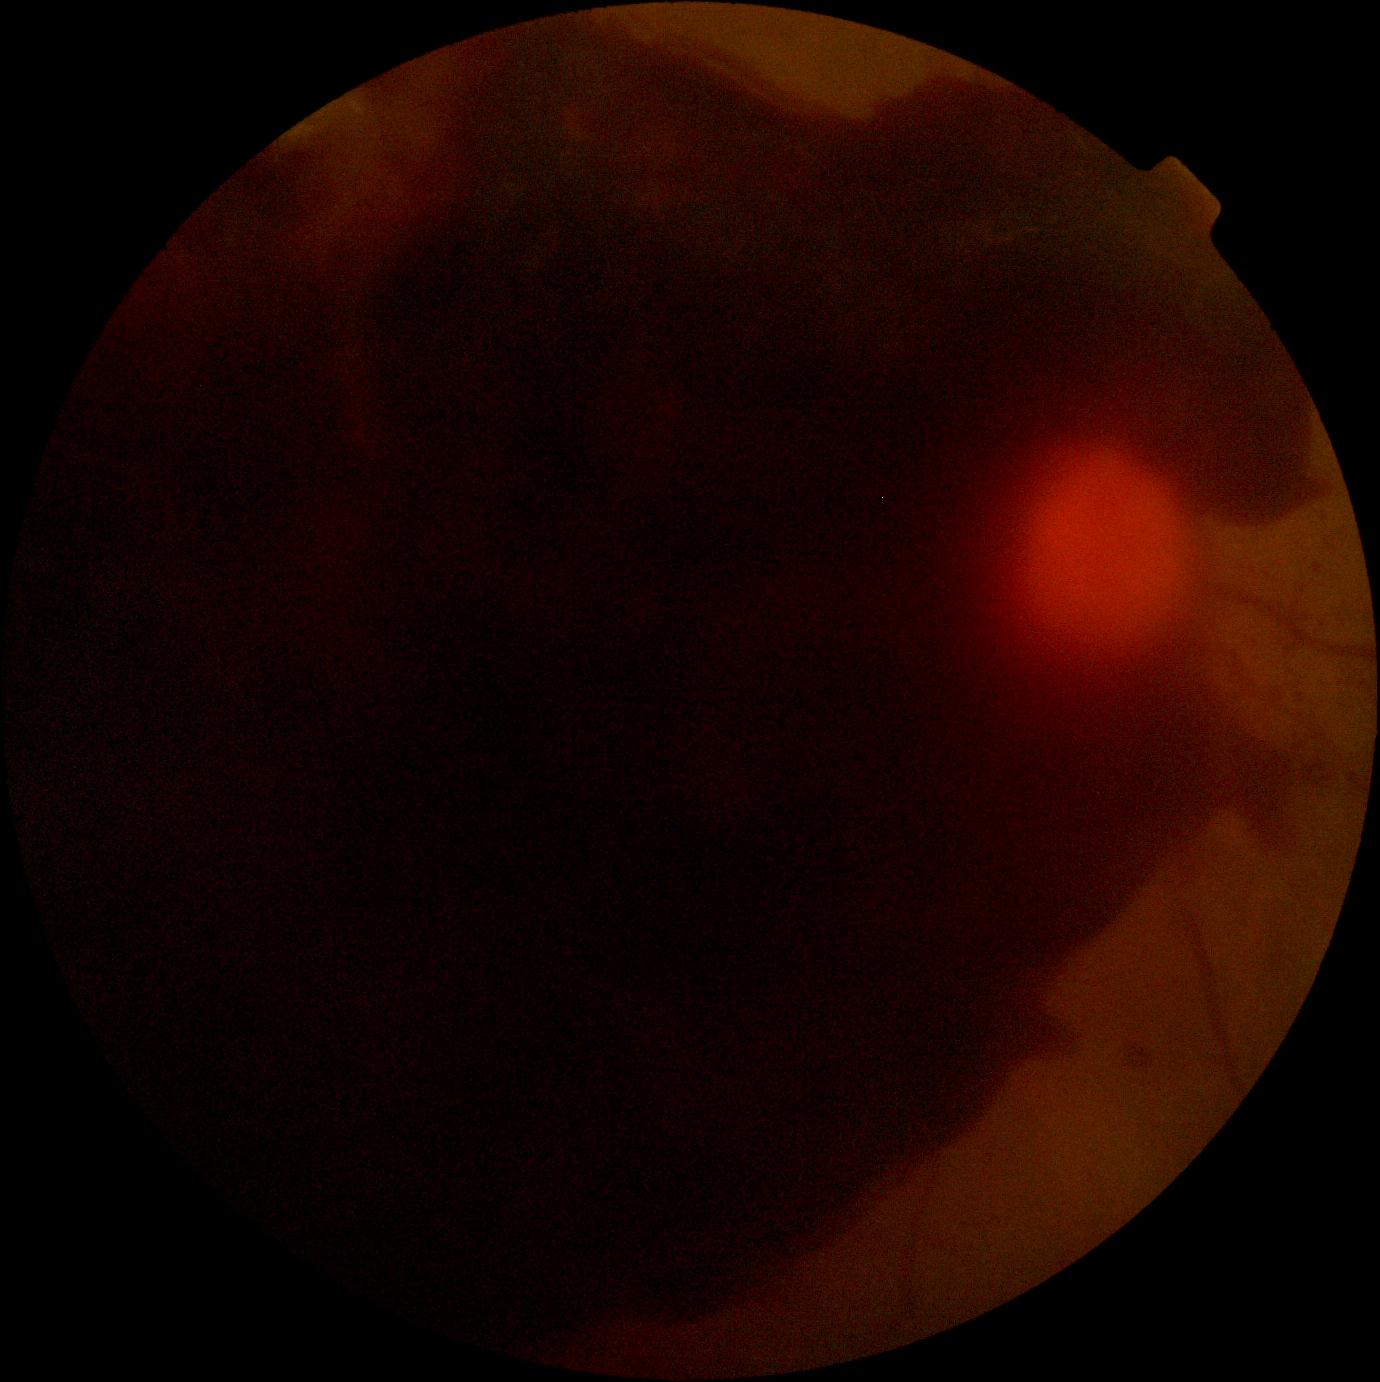

The retinopathy is classified as proliferative diabetic retinopathy. DR severity: proliferative diabetic retinopathy (grade 4).